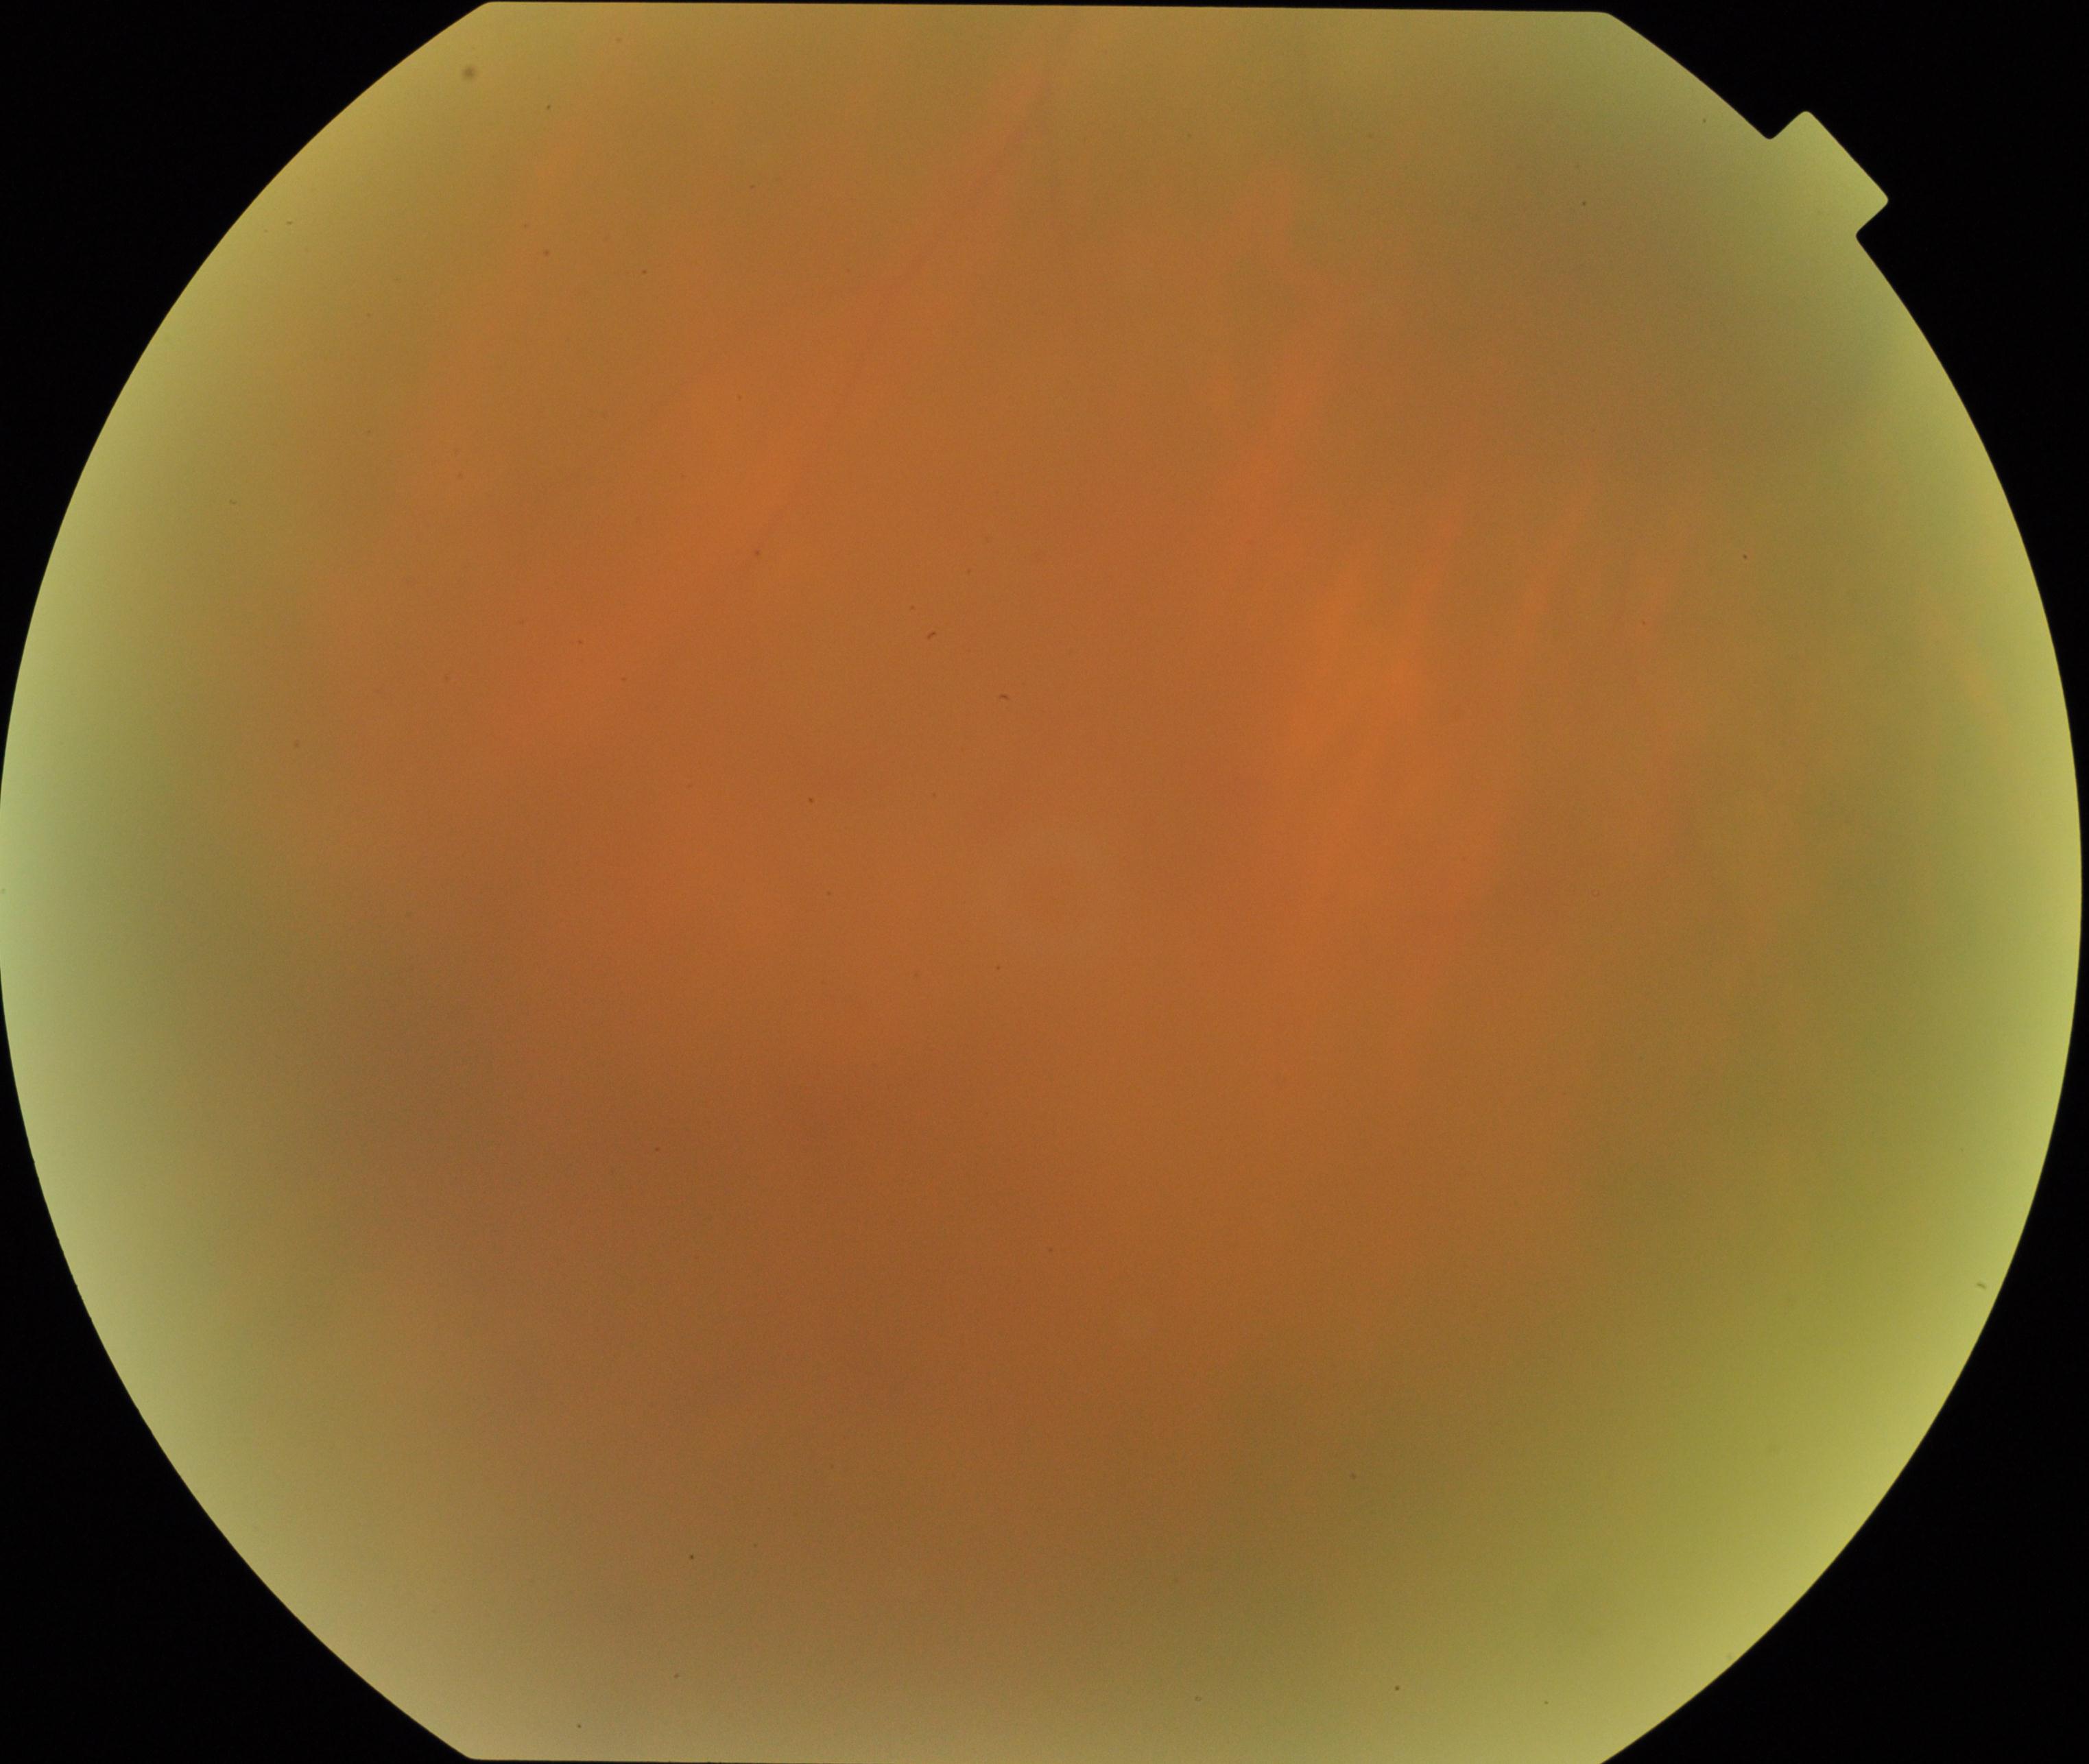

Image quality: blurred, more than half the field obscured. Proliferative retinopathy: no evidence.